CFP:
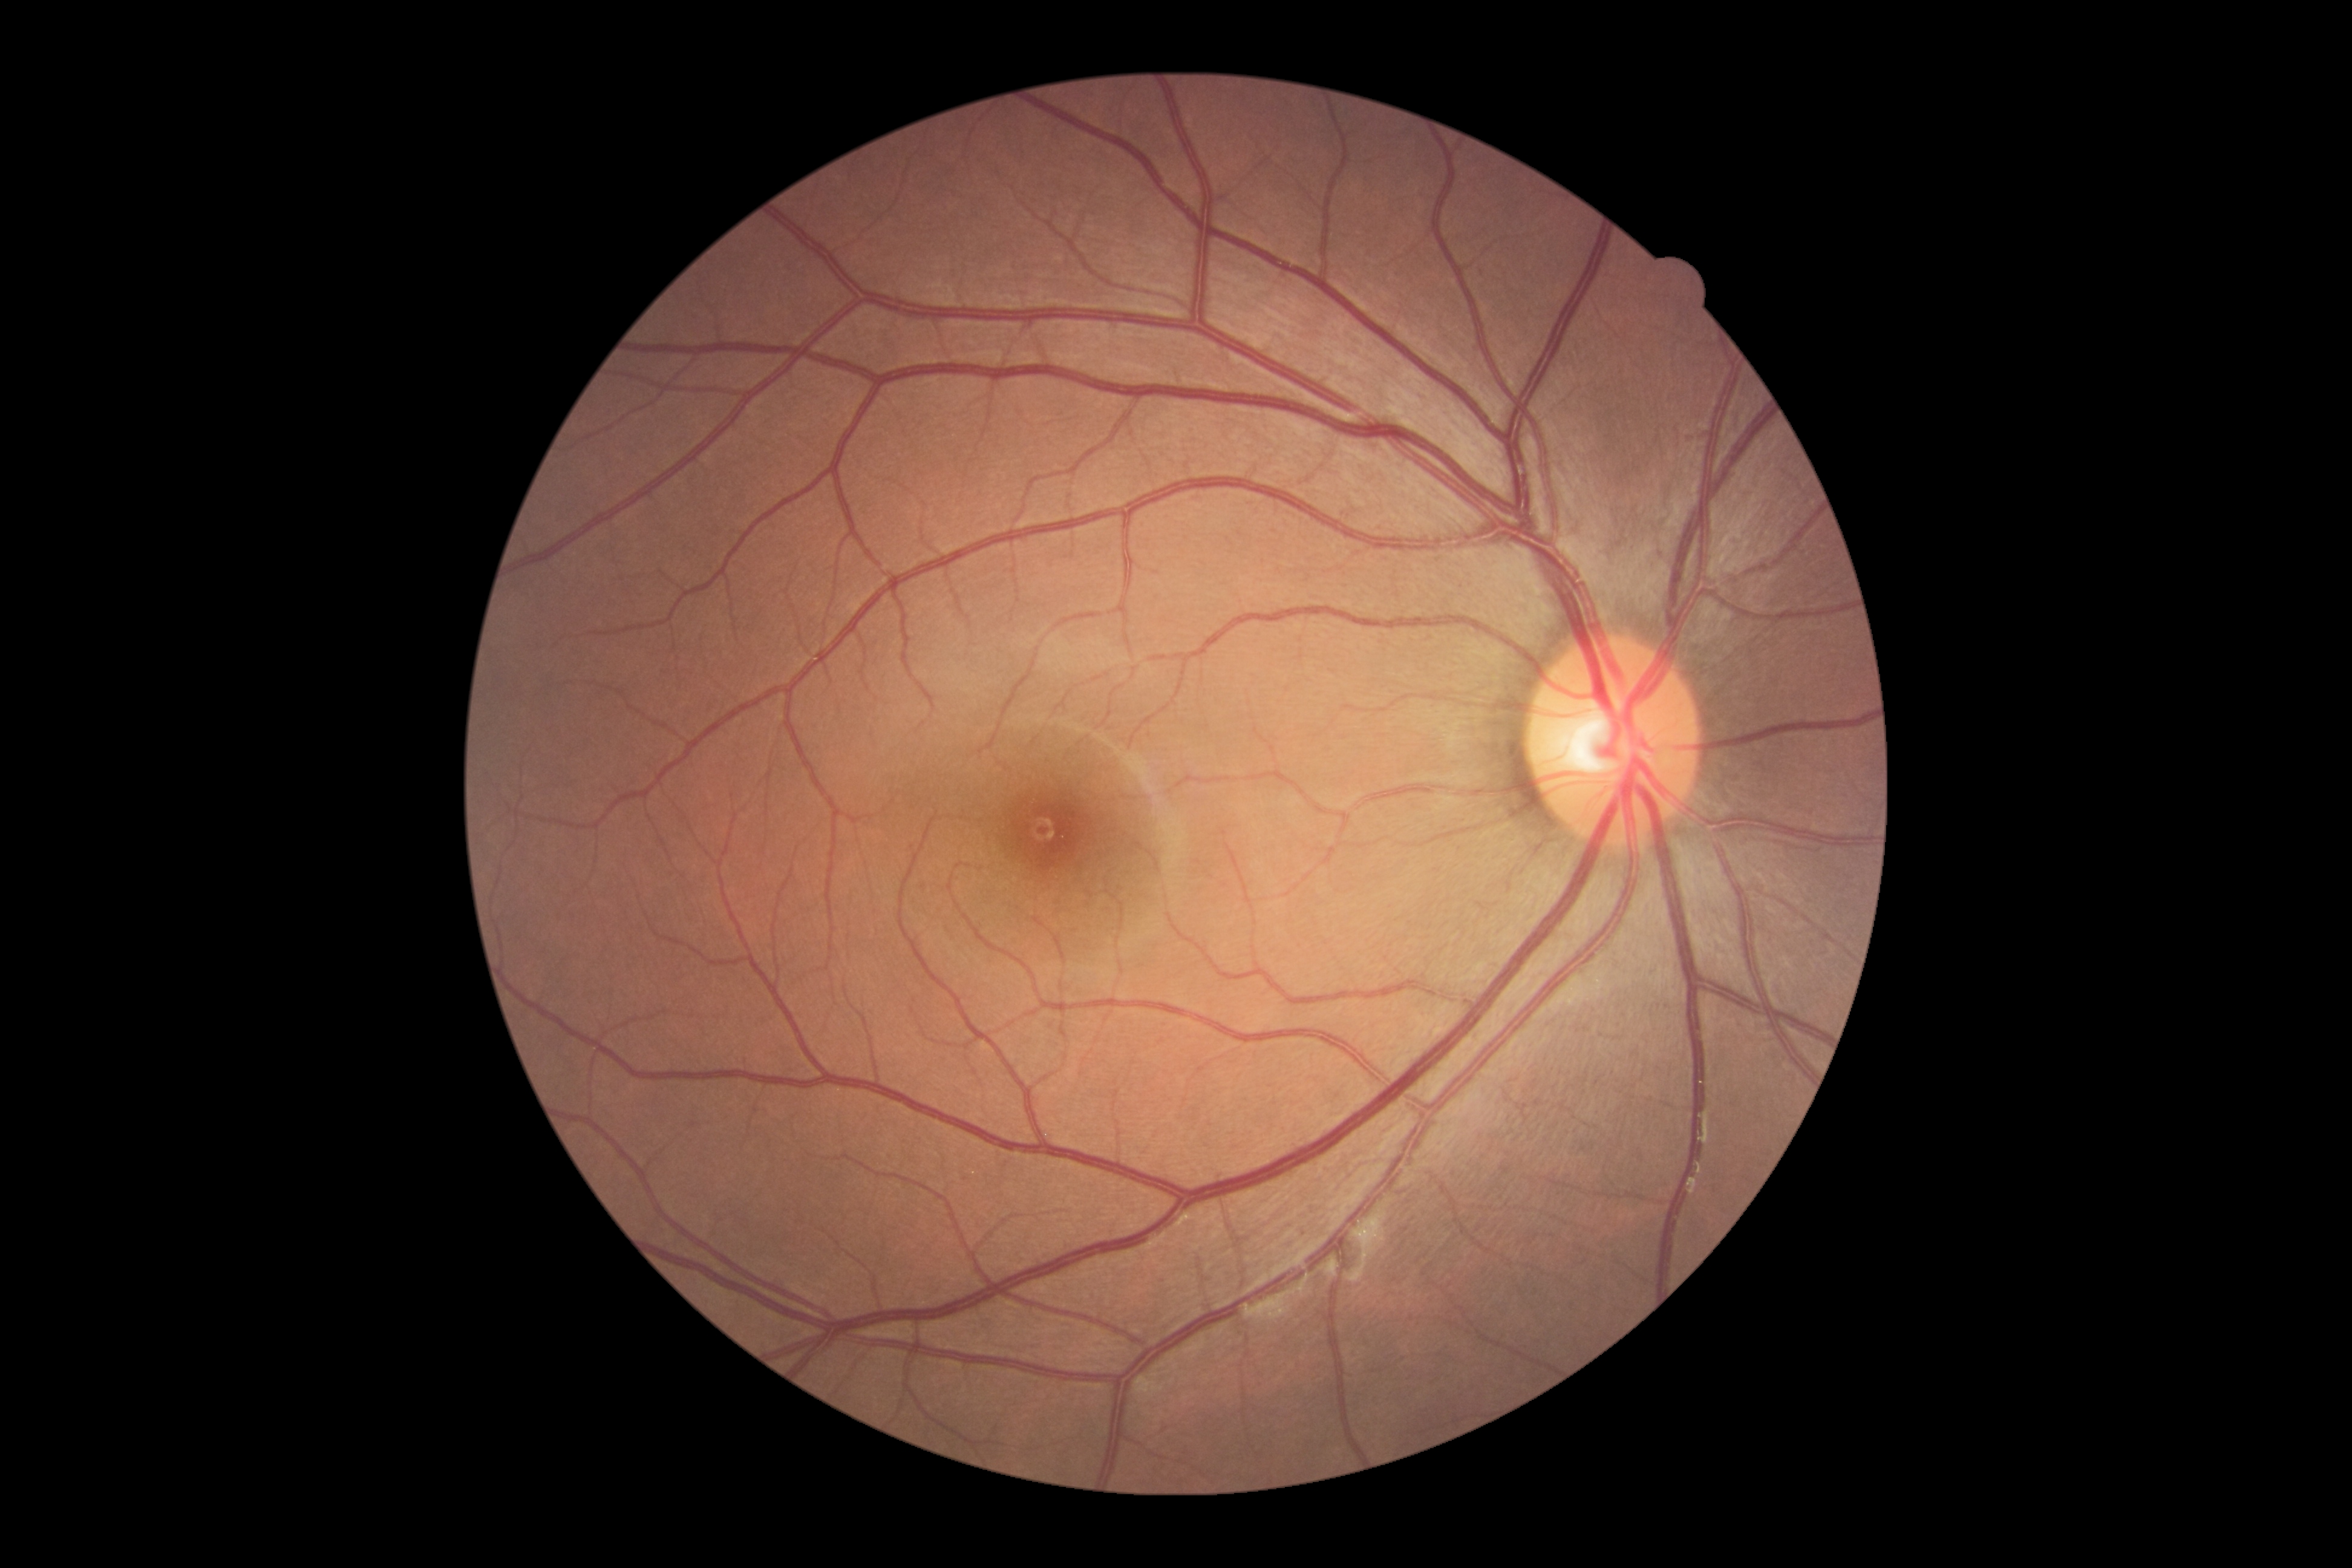 Diabetic retinopathy (DR): grade 0 (no apparent retinopathy).